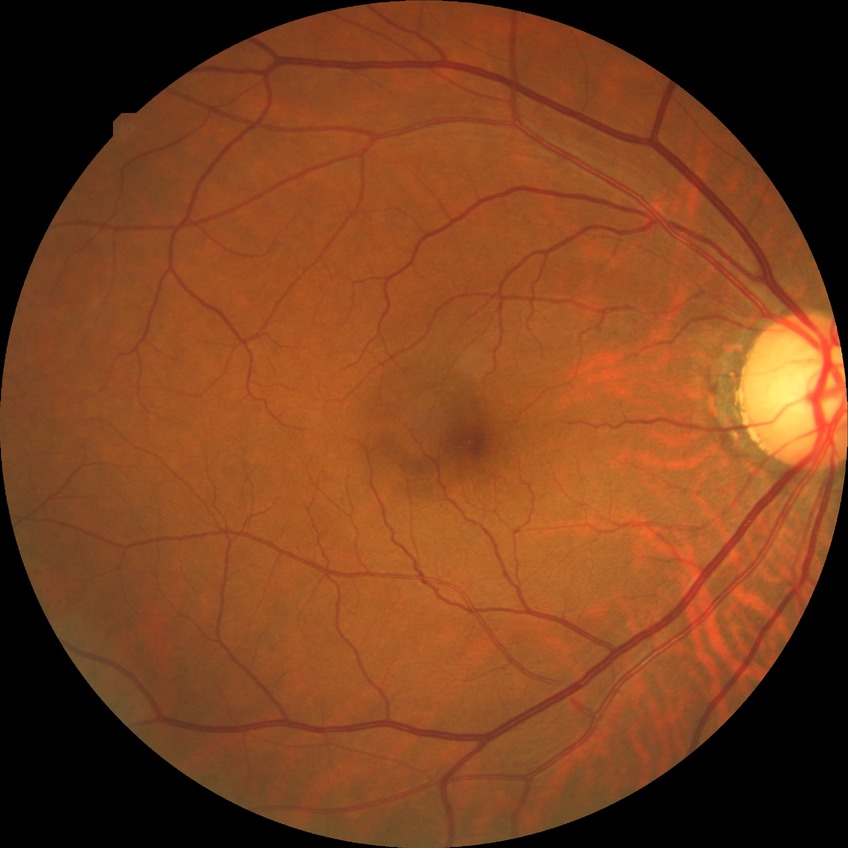

Diabetic retinopathy (DR) is no diabetic retinopathy (NDR).